45° FOV · image size 2212x1662 · fundus photo:
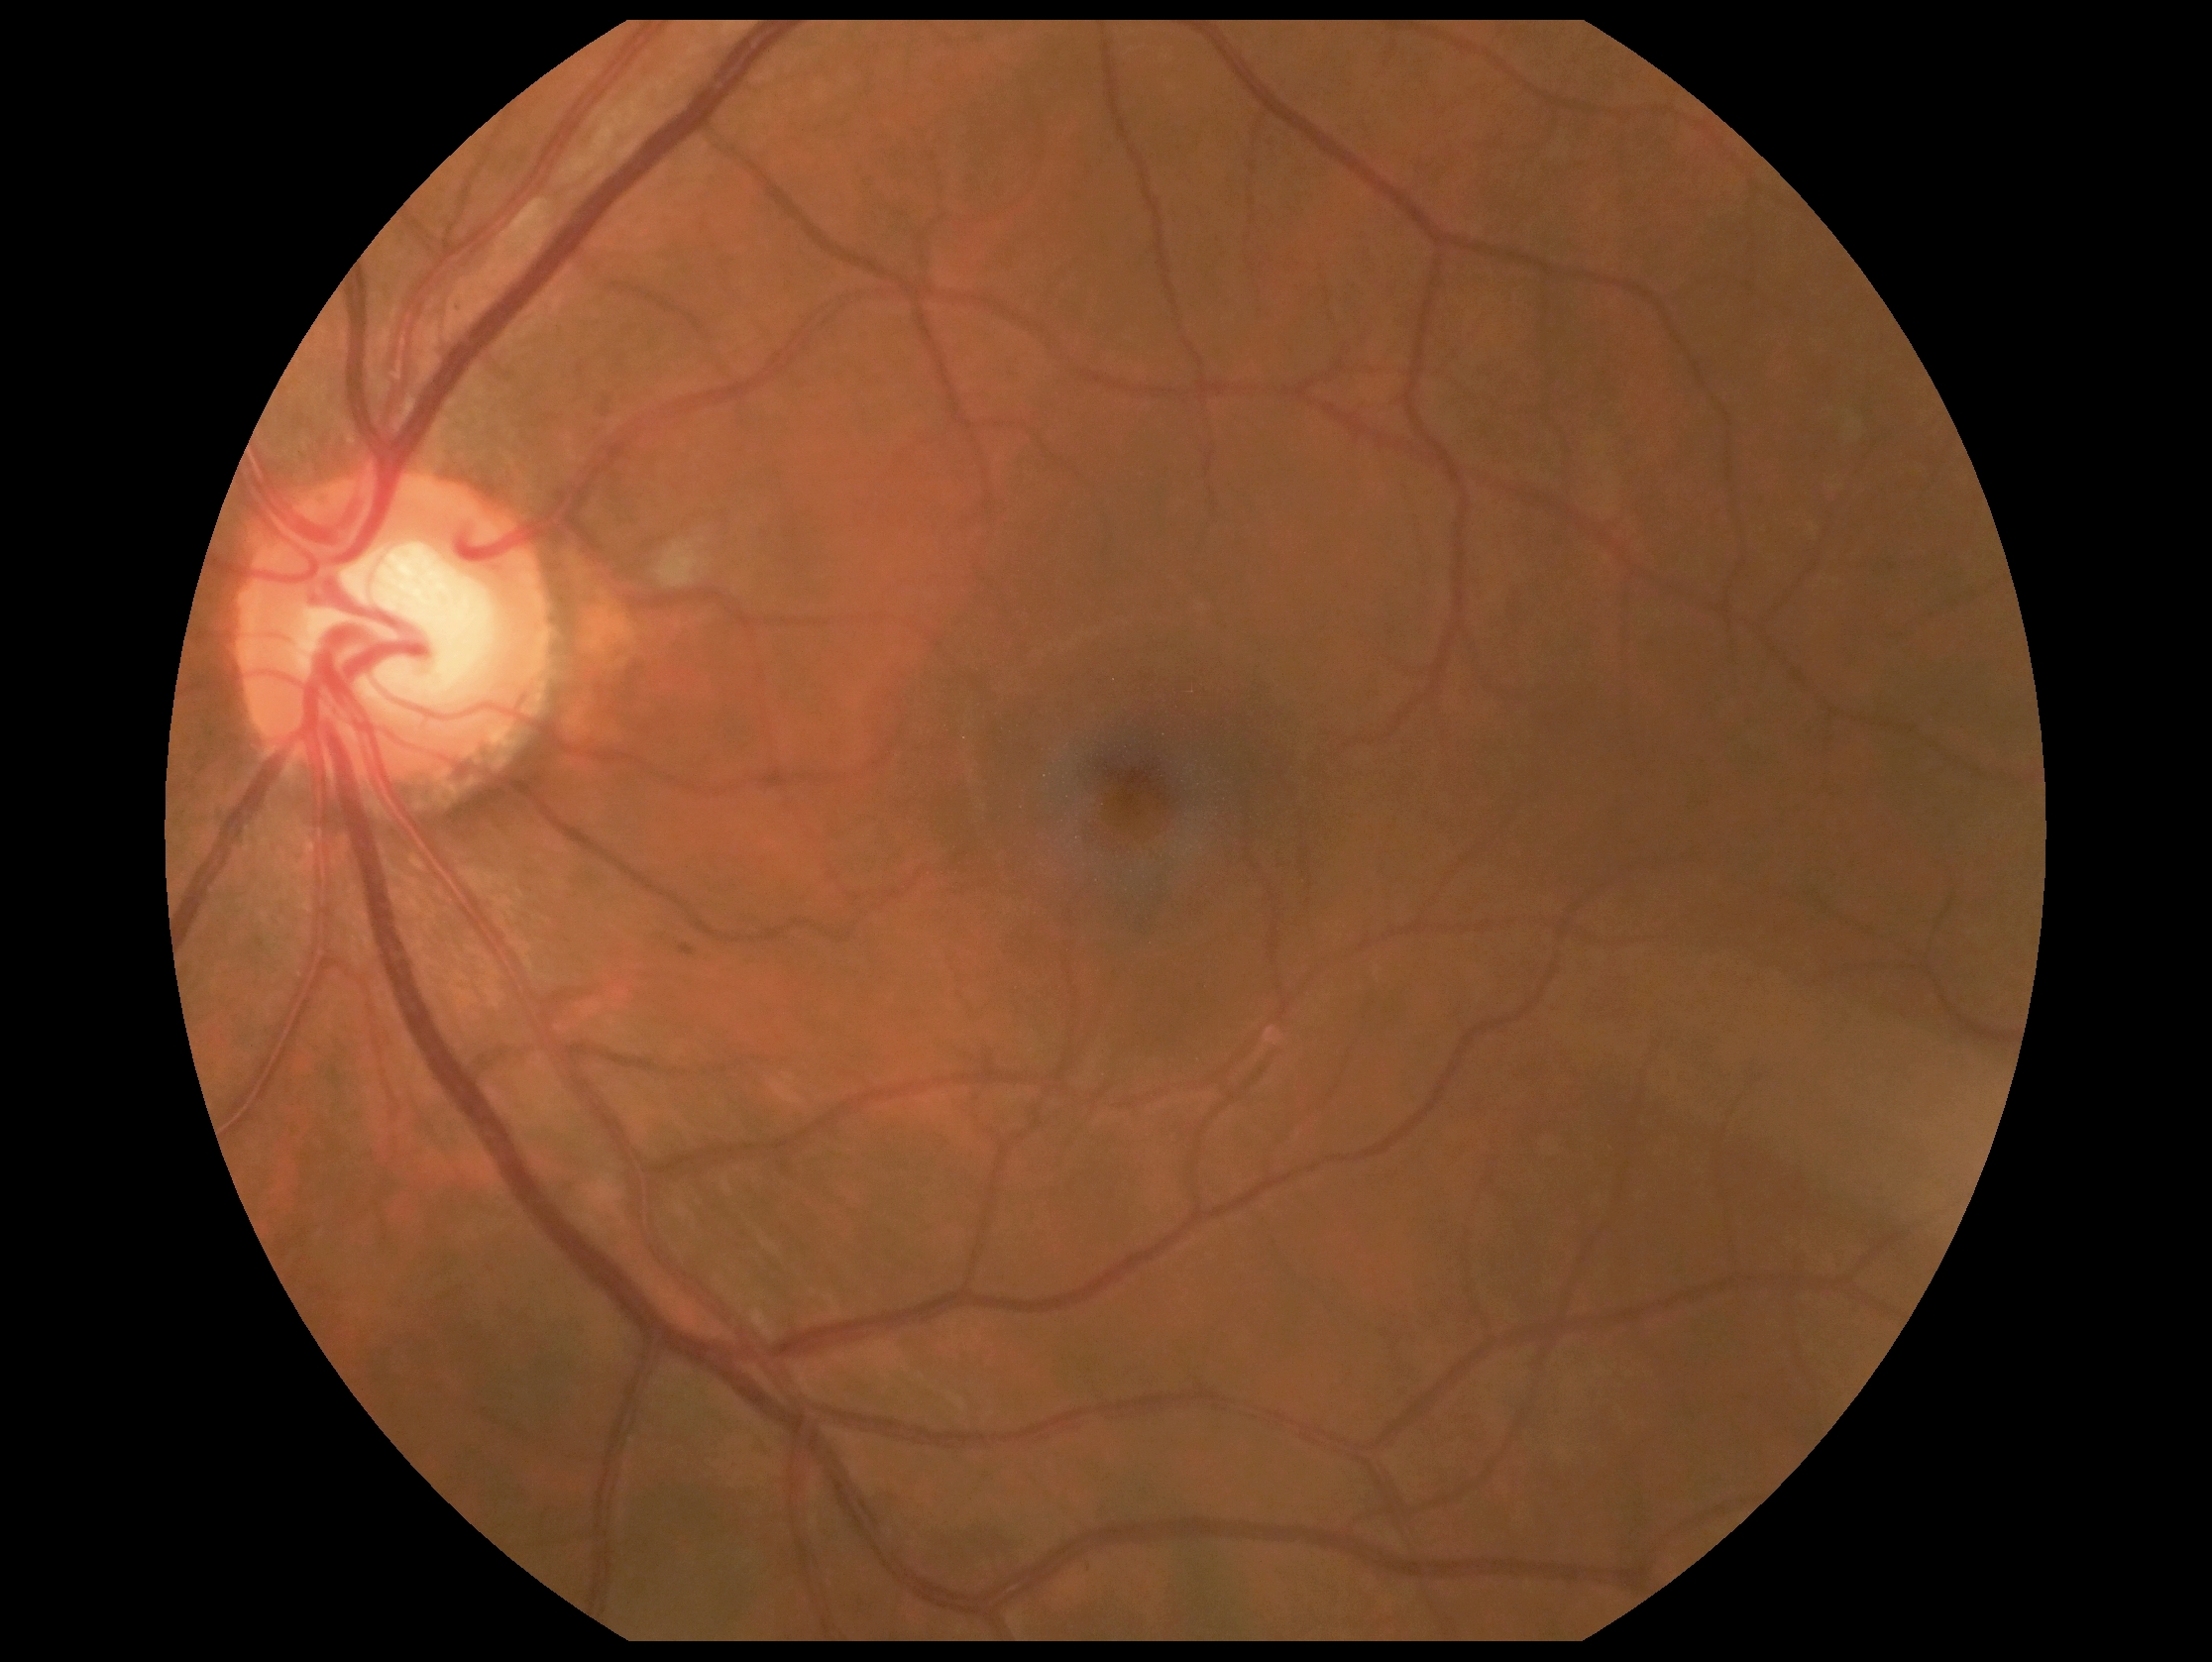
diabetic retinopathy (DR): grade 2 (moderate NPDR) — more than just microaneurysms but less than severe NPDR.